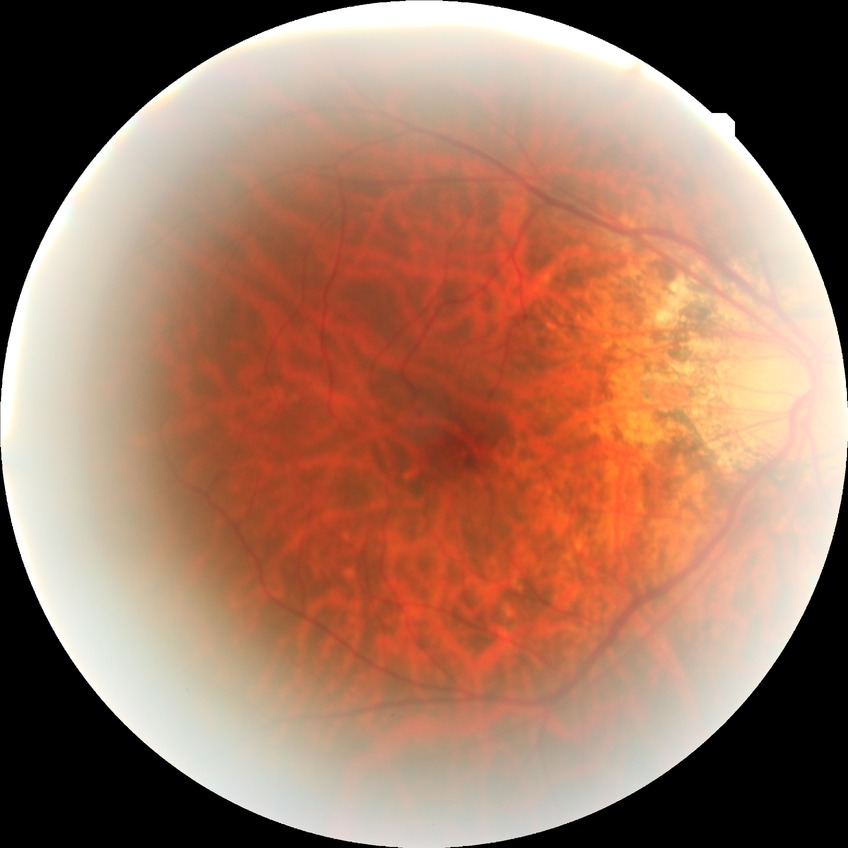

Diabetic retinopathy (DR) is no diabetic retinopathy (NDR).